Retinal fundus photograph.
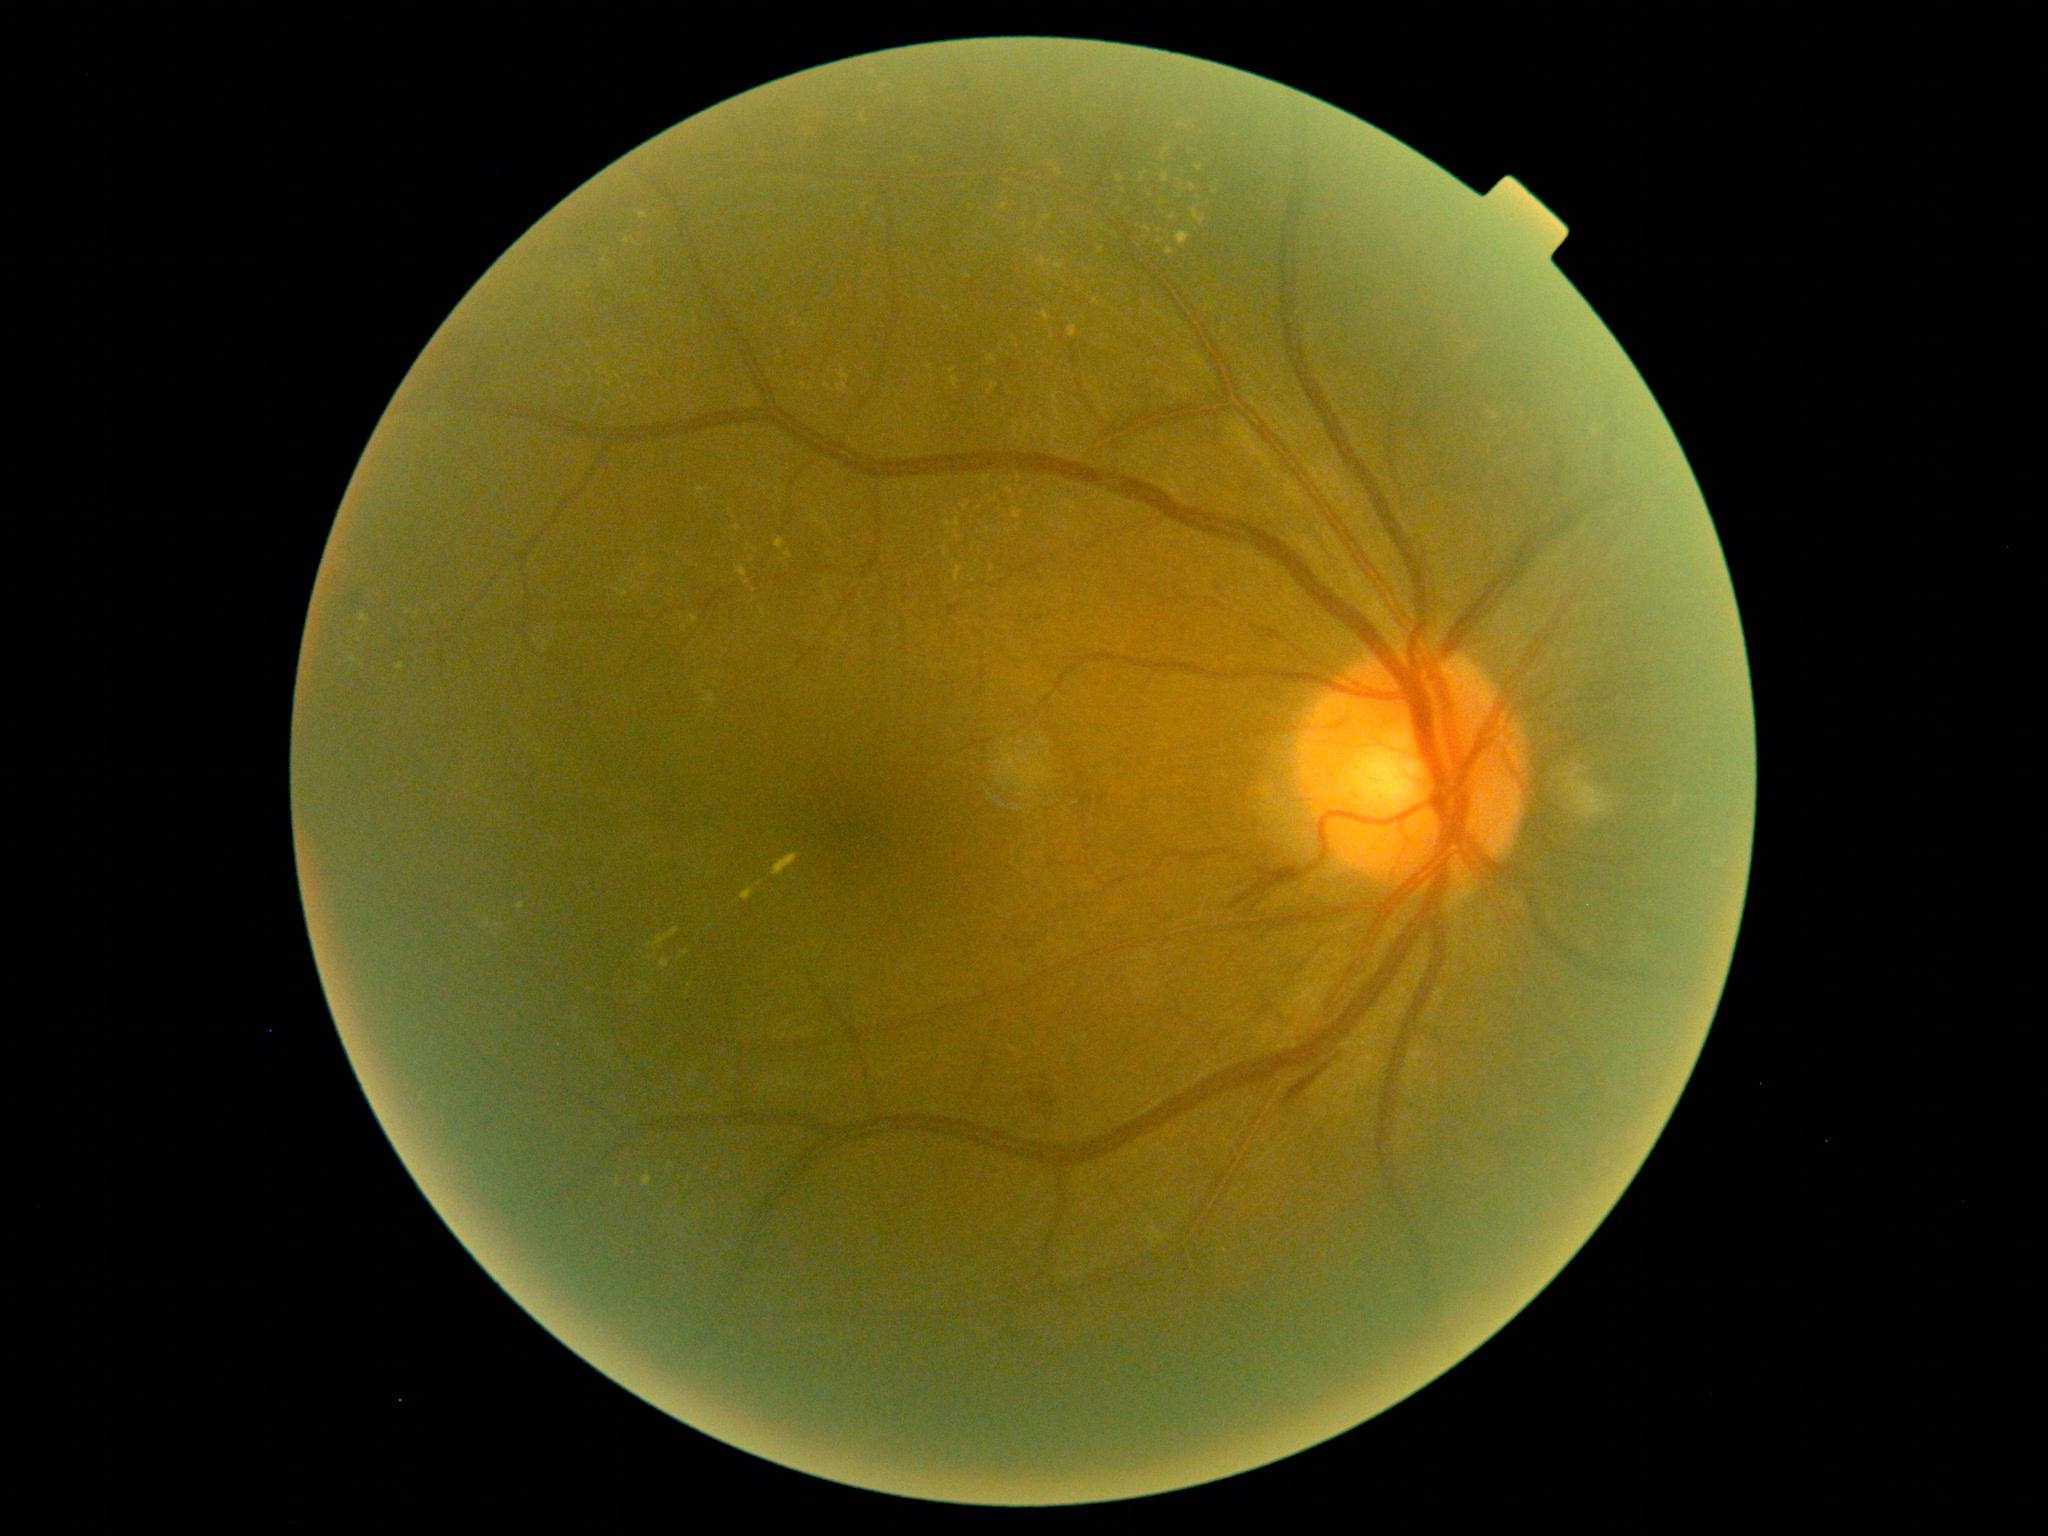 Findings:
– diabetic retinopathy (DR): grade 2